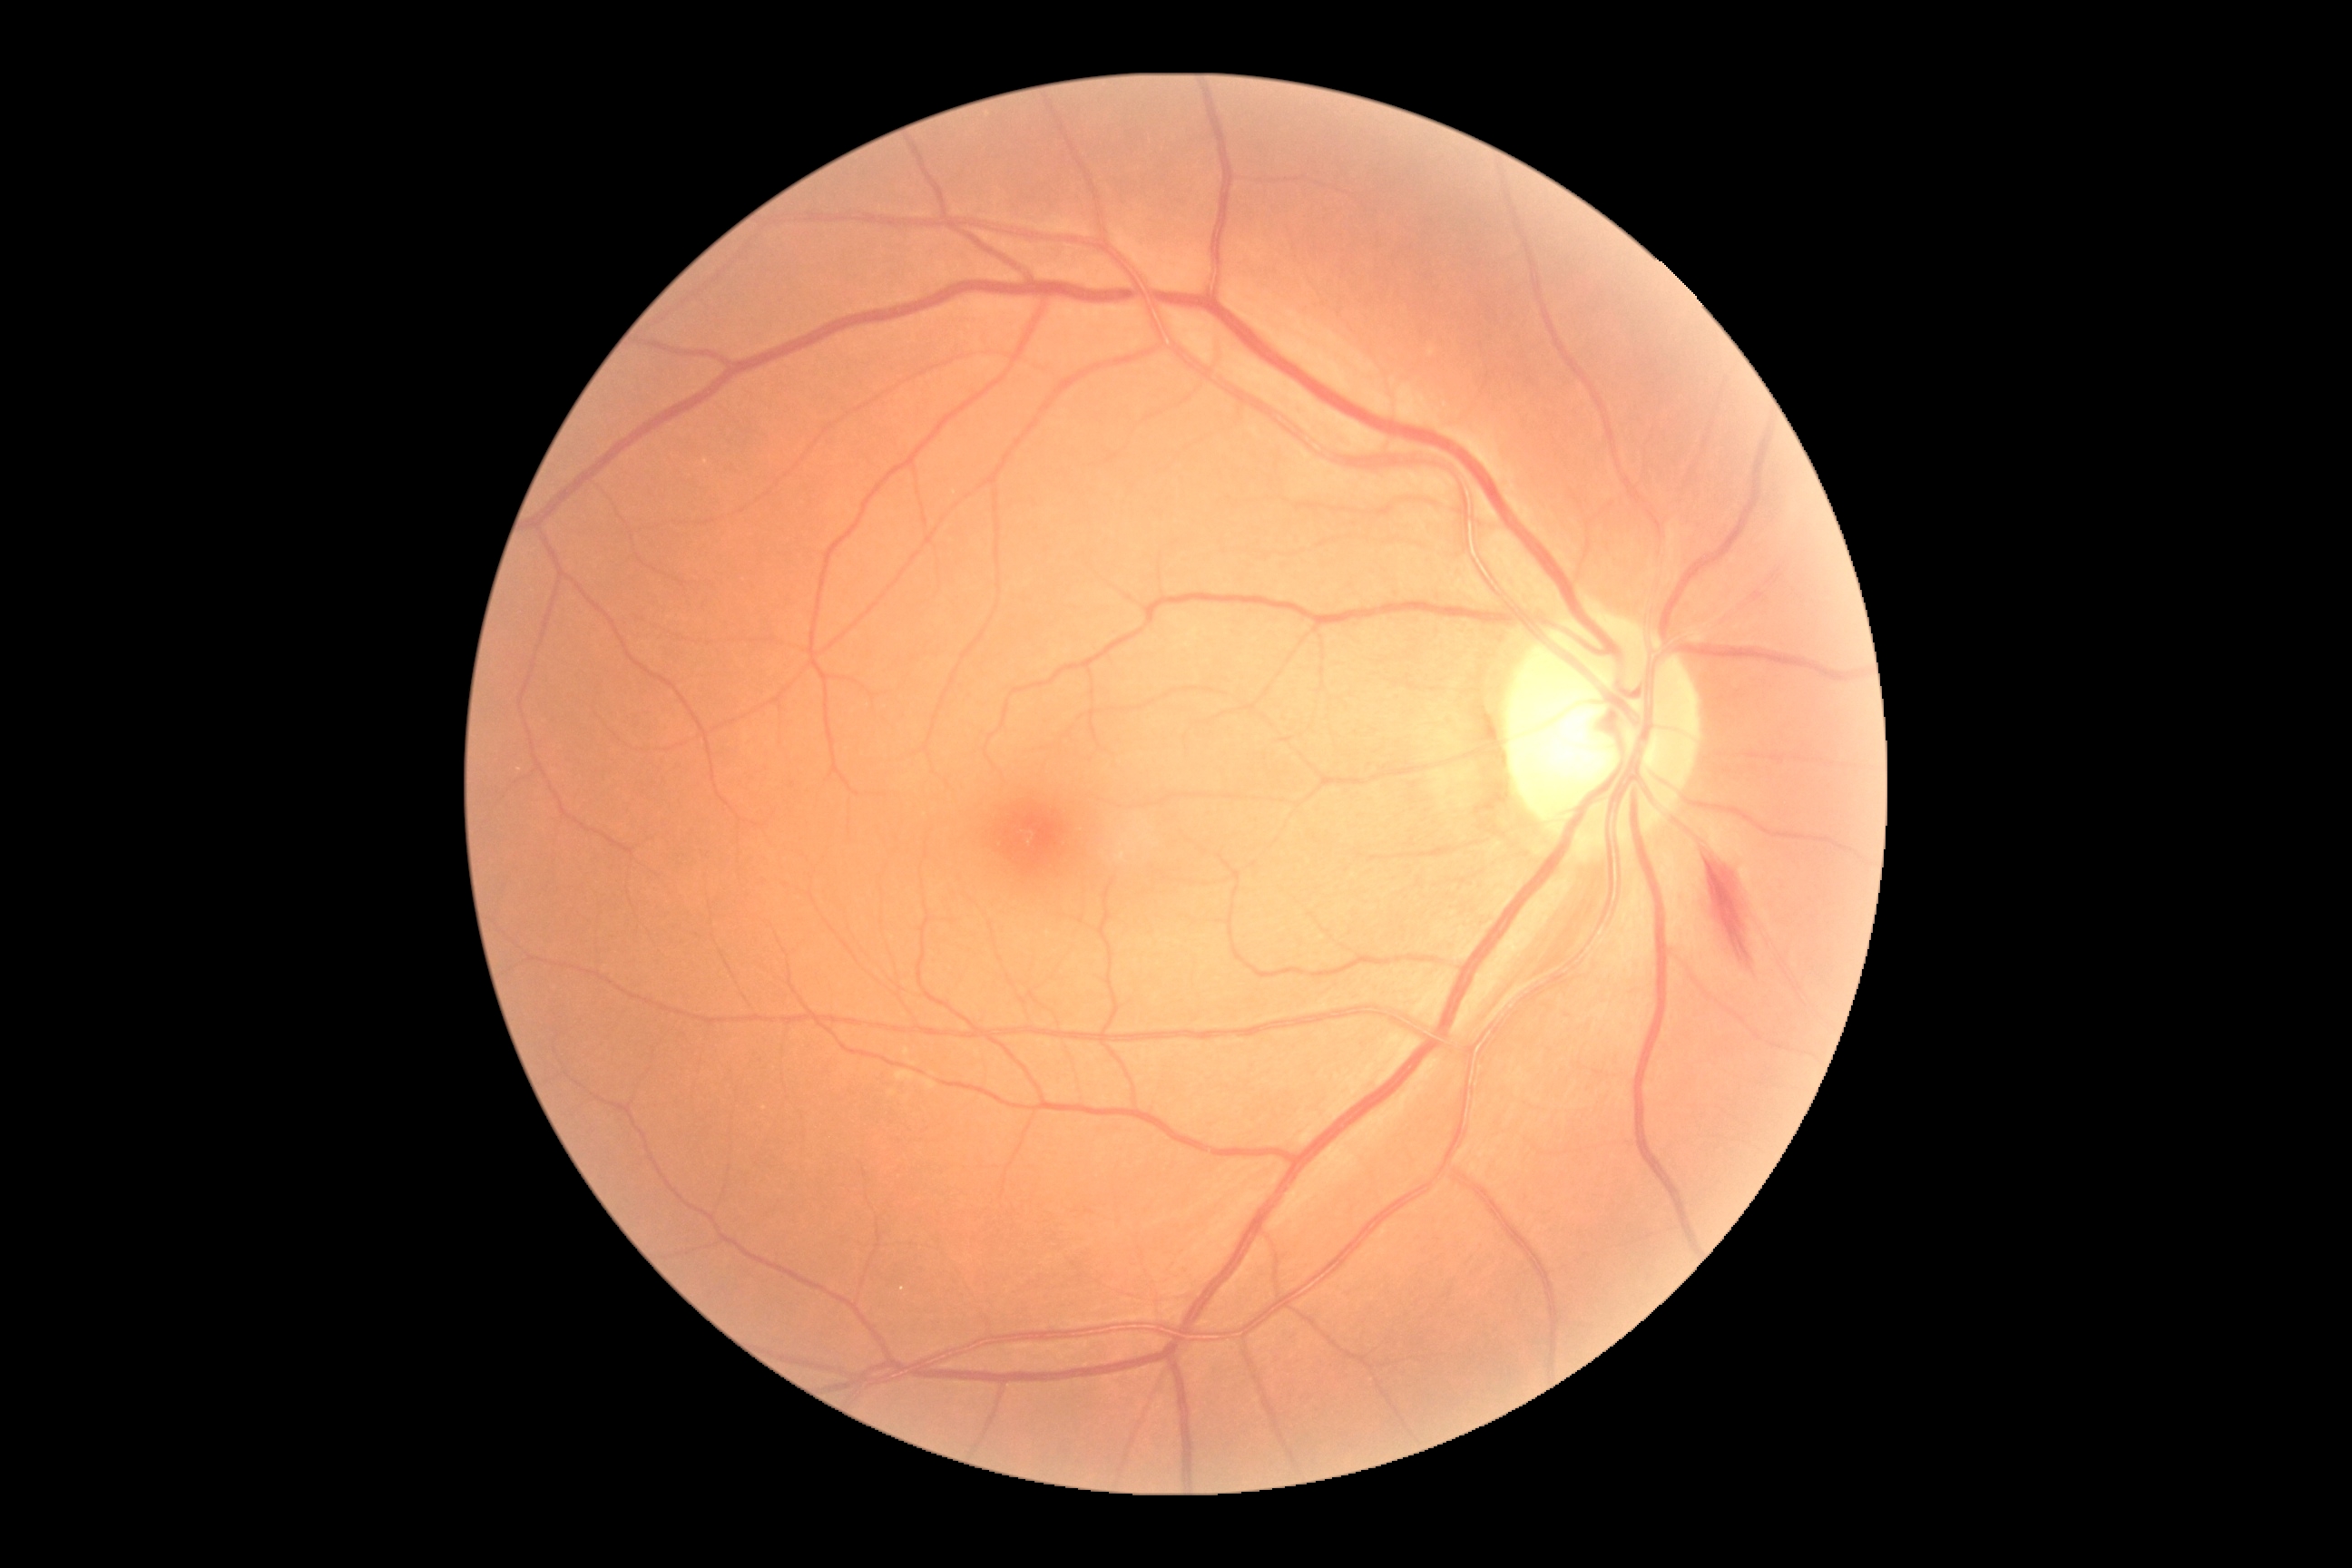

<lesions>
  <dr_grade>2</dr_grade>
  <se />
  <ex />
  <he>(1709, 865, 1754, 972)</he>
  <ma />
</lesions>